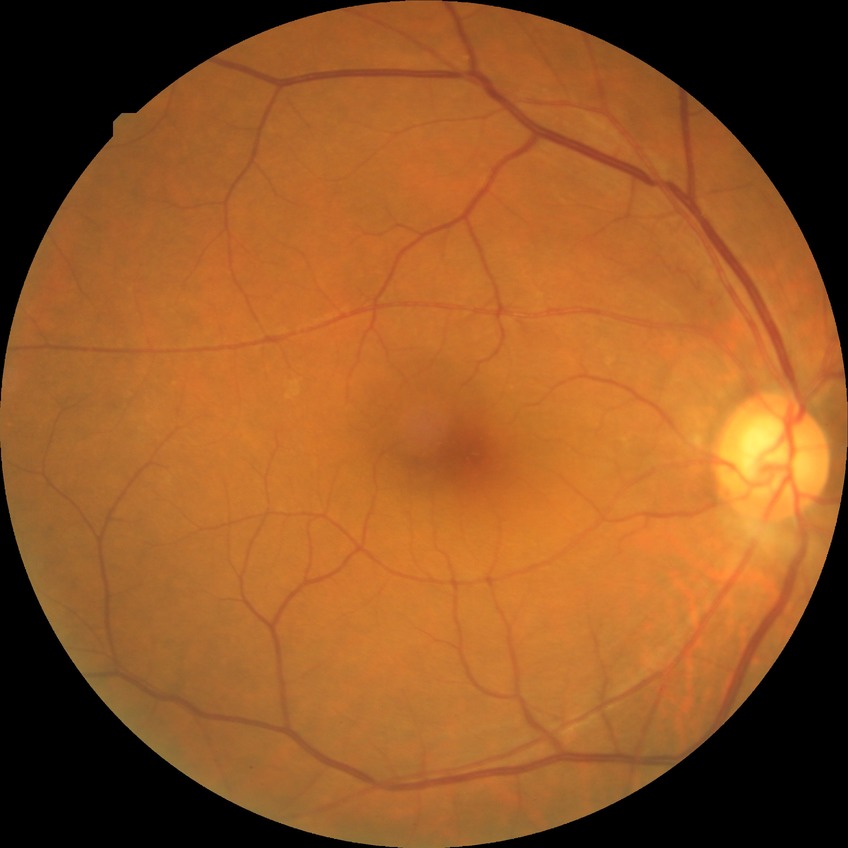 DR grade: NDR.